2212 by 1659 pixels: 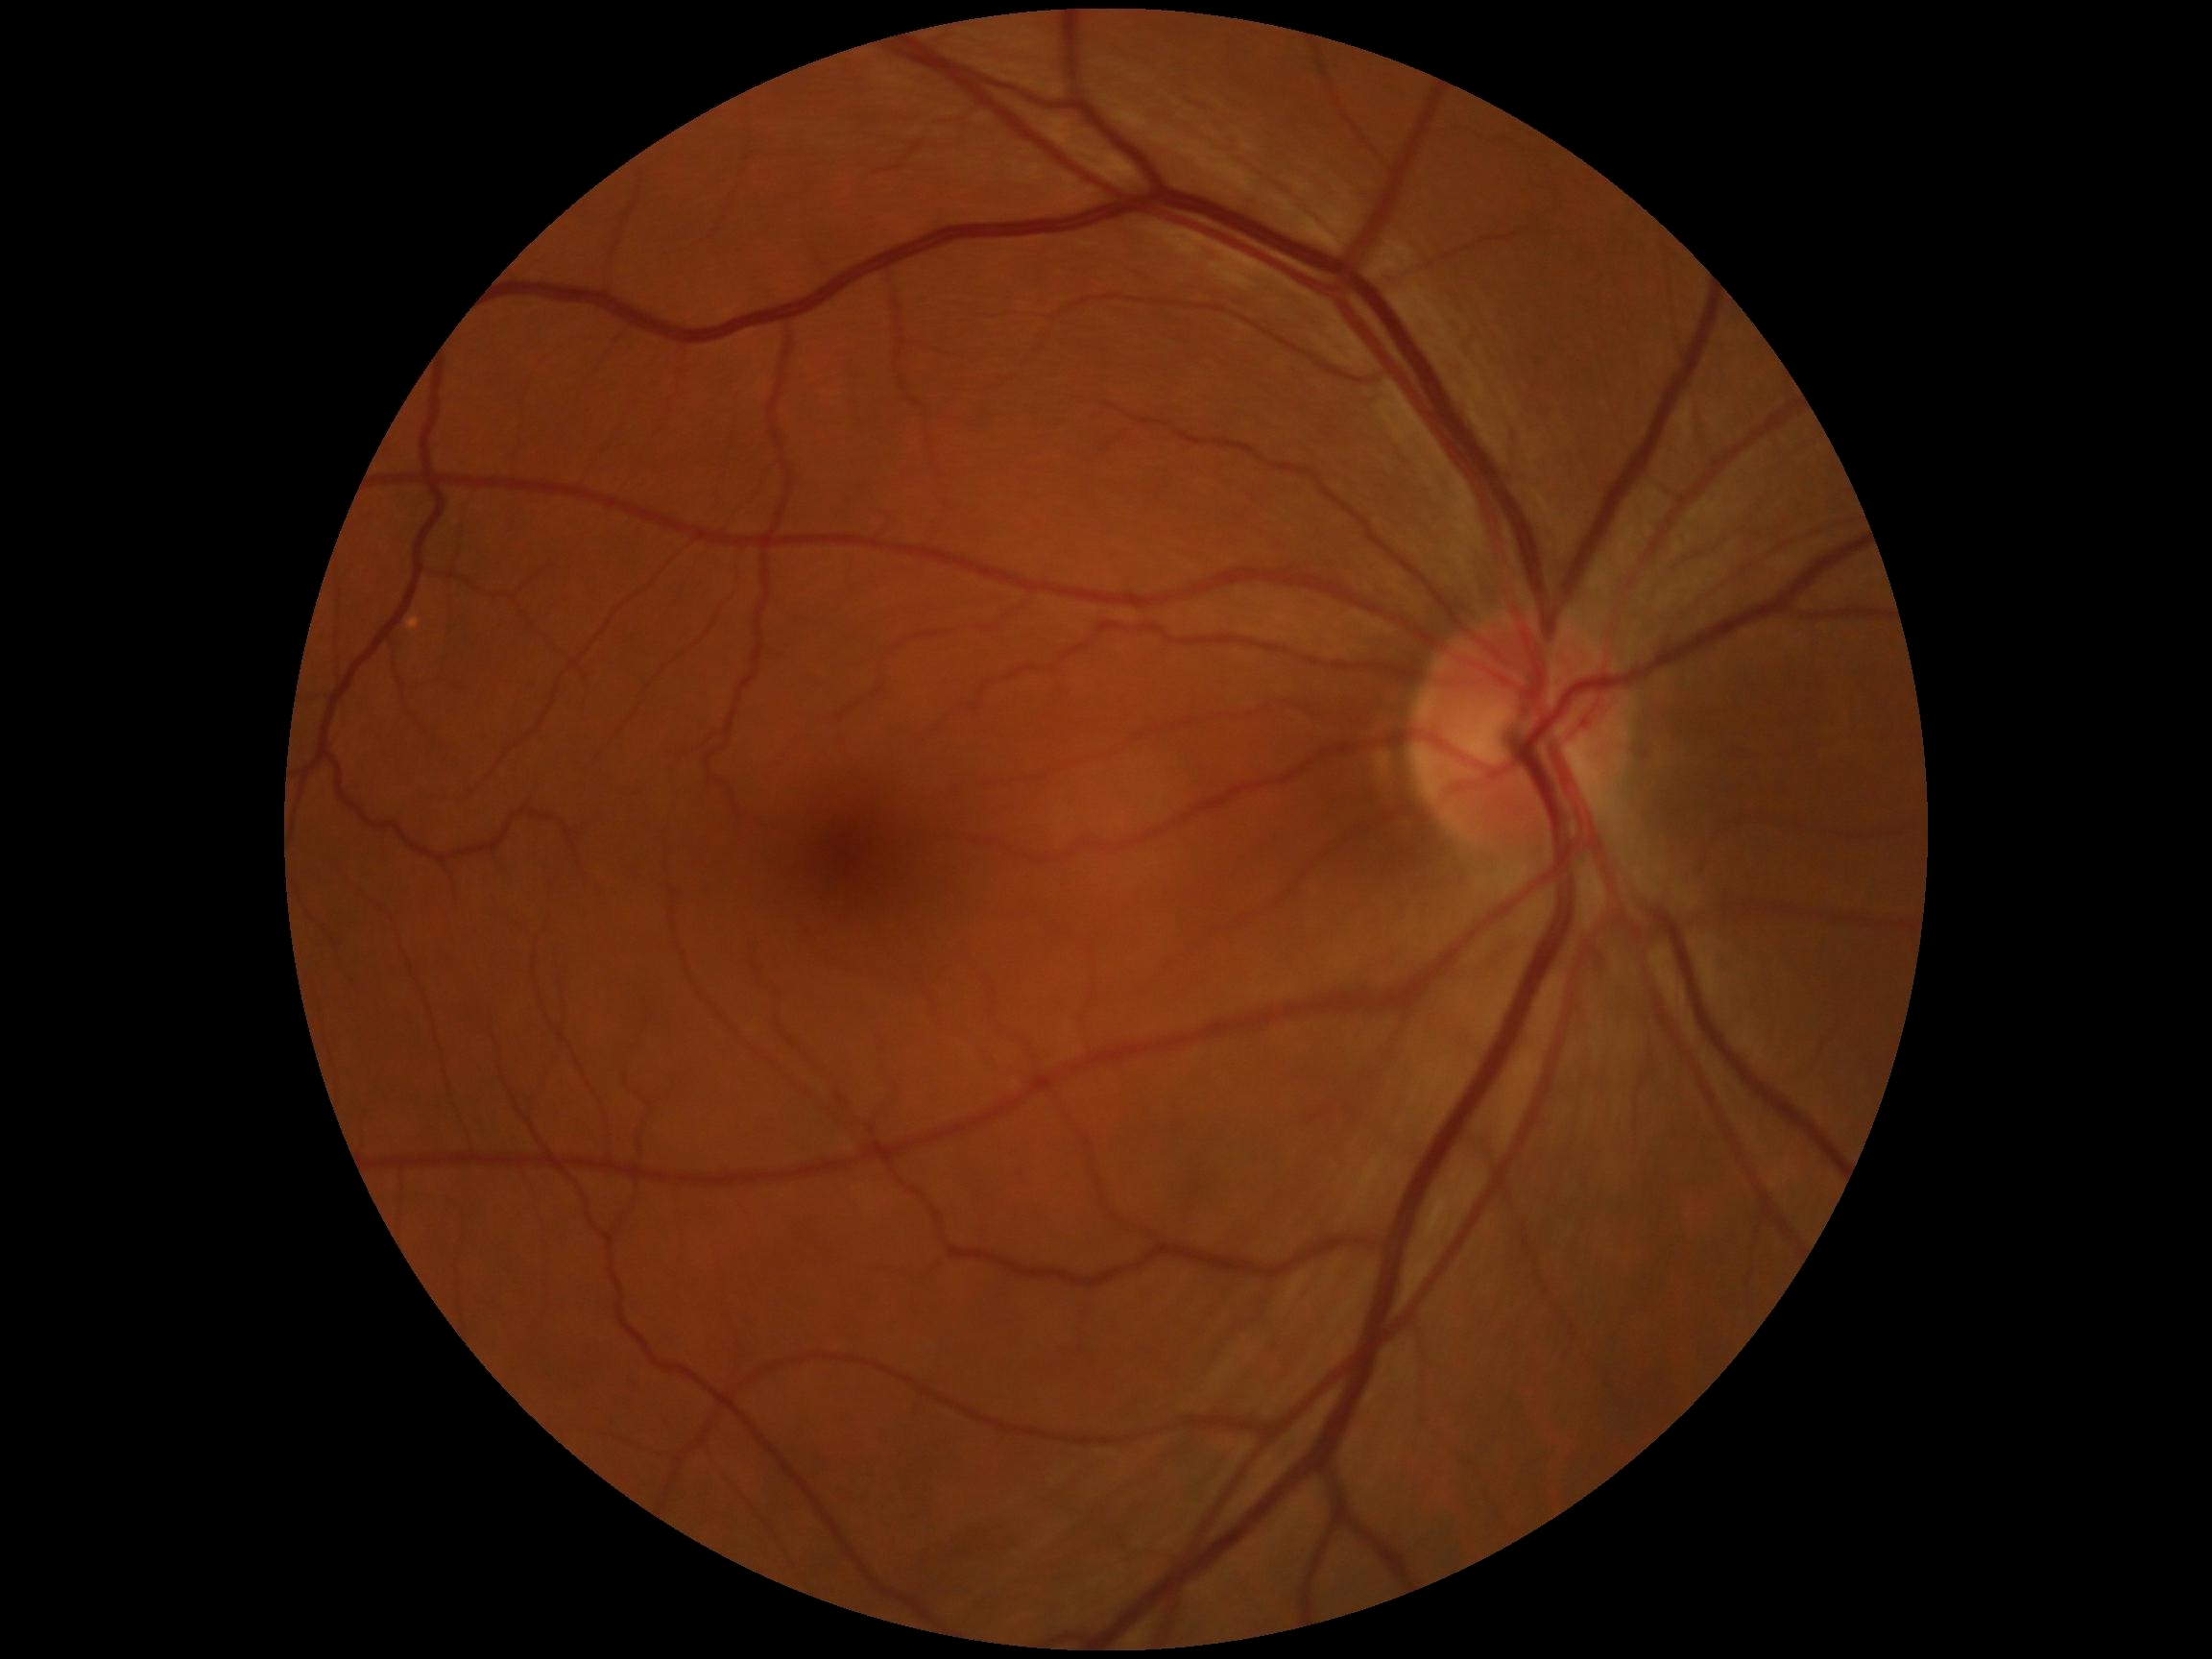

DR: no apparent retinopathy (grade 0).
No DR findings.